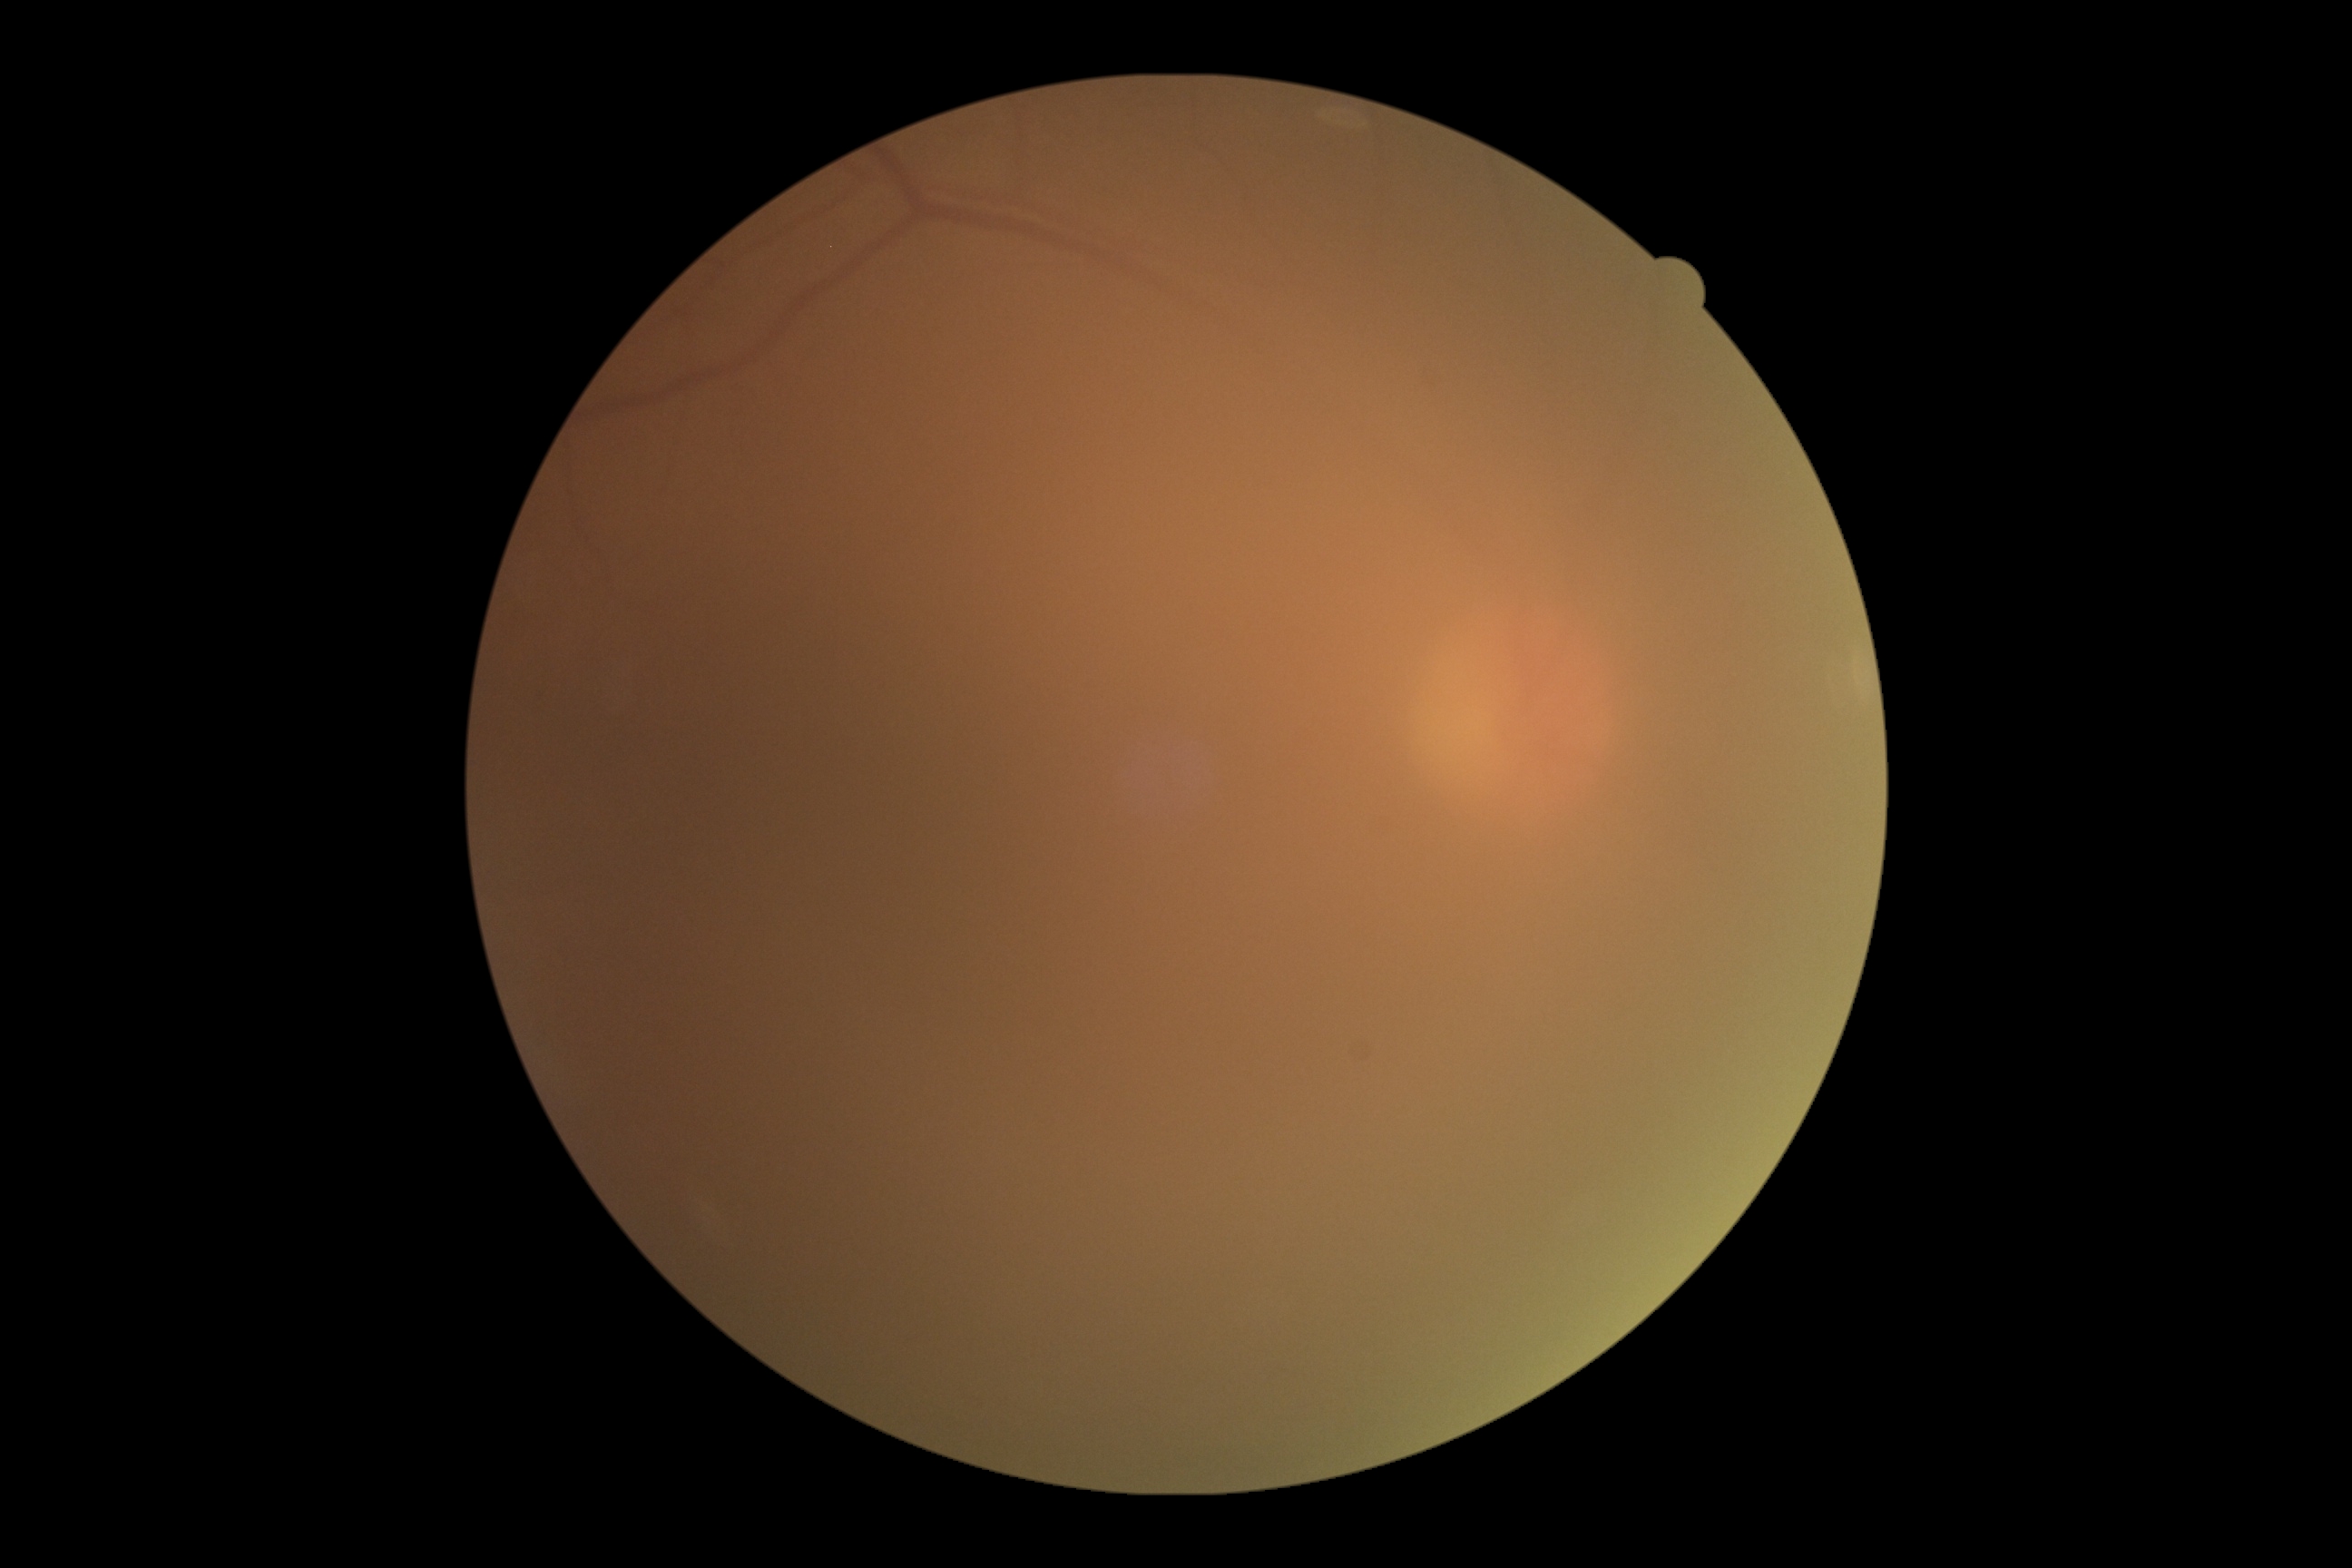
Annotations:
– DR severity: ungradable due to poor image quality